Infant wide-field fundus photograph; 130° field of view (Clarity RetCam 3):
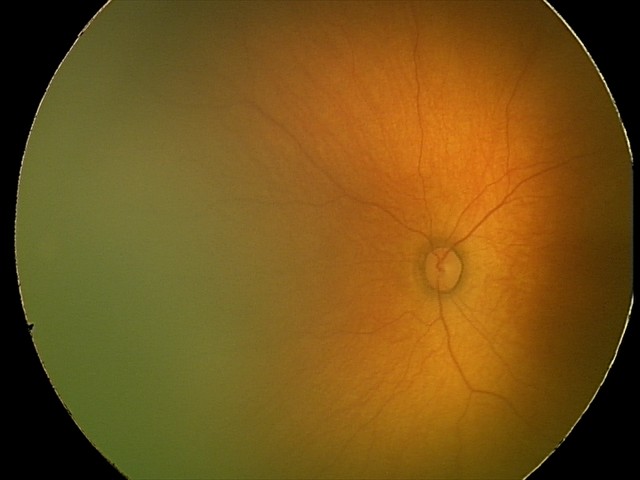
Screening series with retinopathy of prematurity (ROP) stage 1.
Without plus disease.